Wide-field fundus image from infant ROP screening.
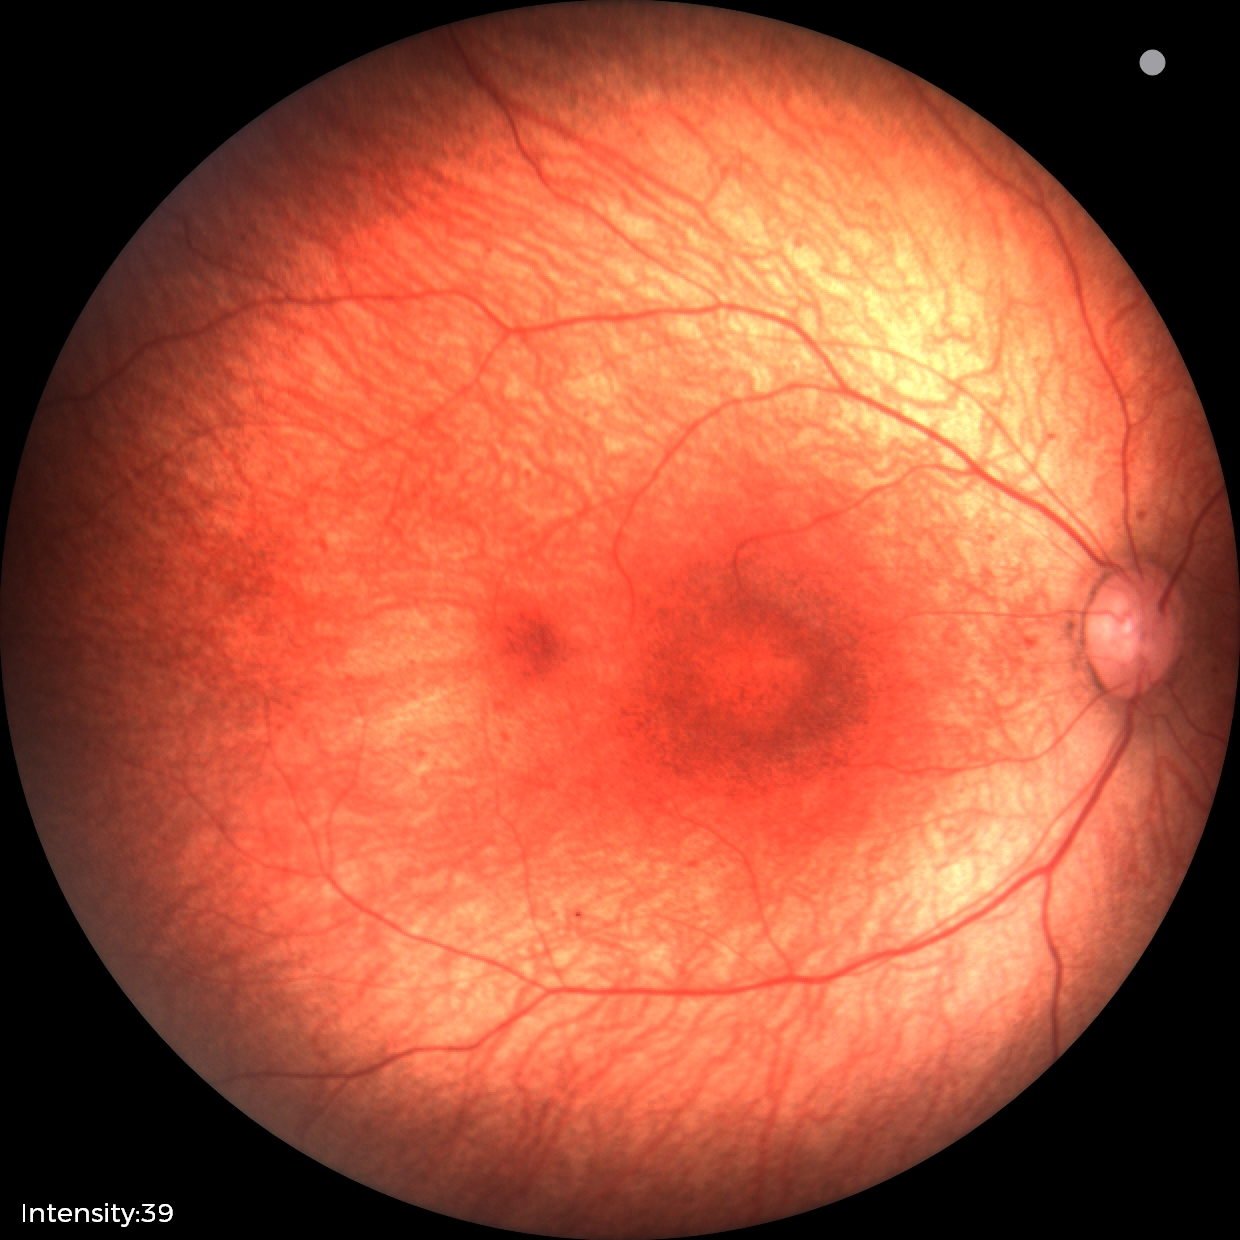 Impression: physiological appearance.